848x848px; 45 degree fundus photograph: 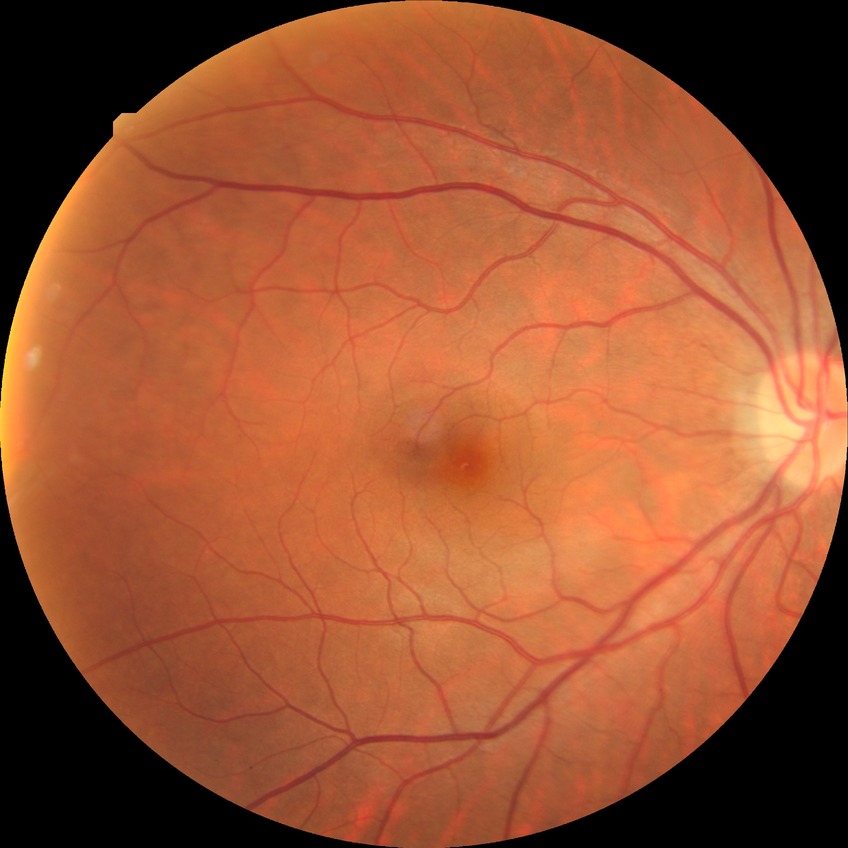
DR impression: no signs of DR; DR grade: NDR.